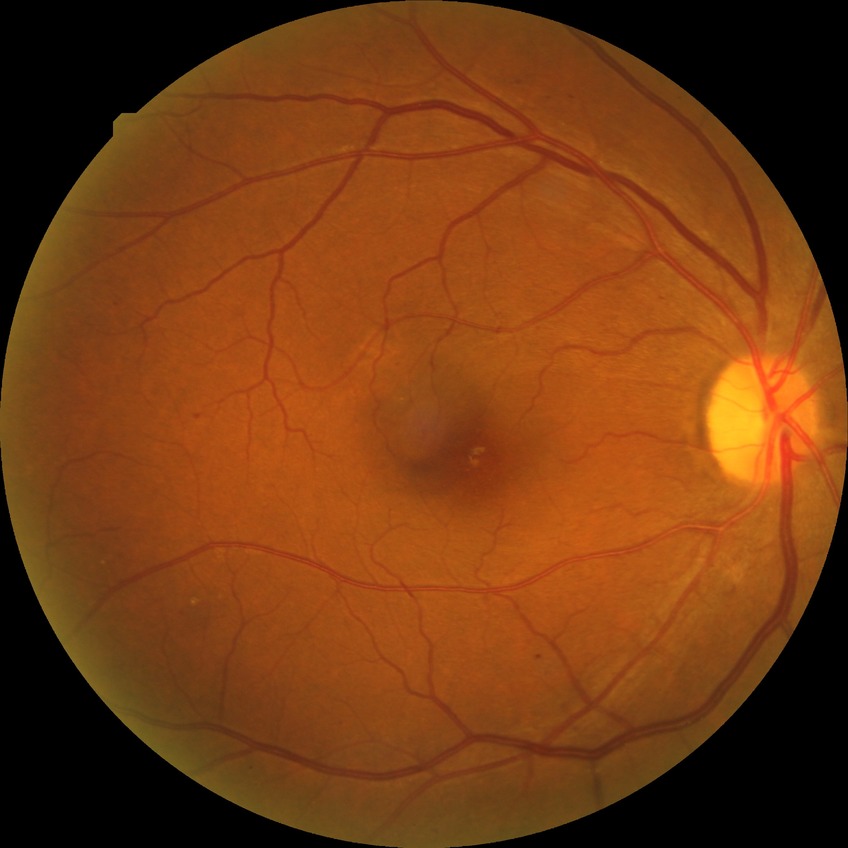
davis_grade: SDR